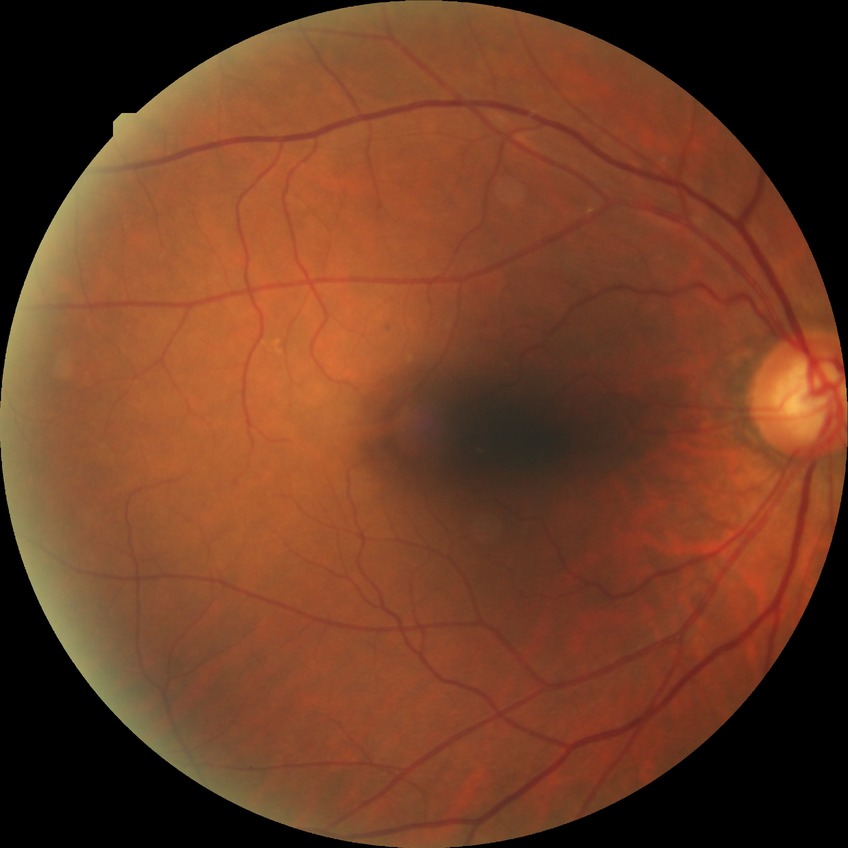
Findings:
– diabetic retinopathy (DR) — NDR (no diabetic retinopathy)